Color fundus image. 2048 by 1536 pixels.
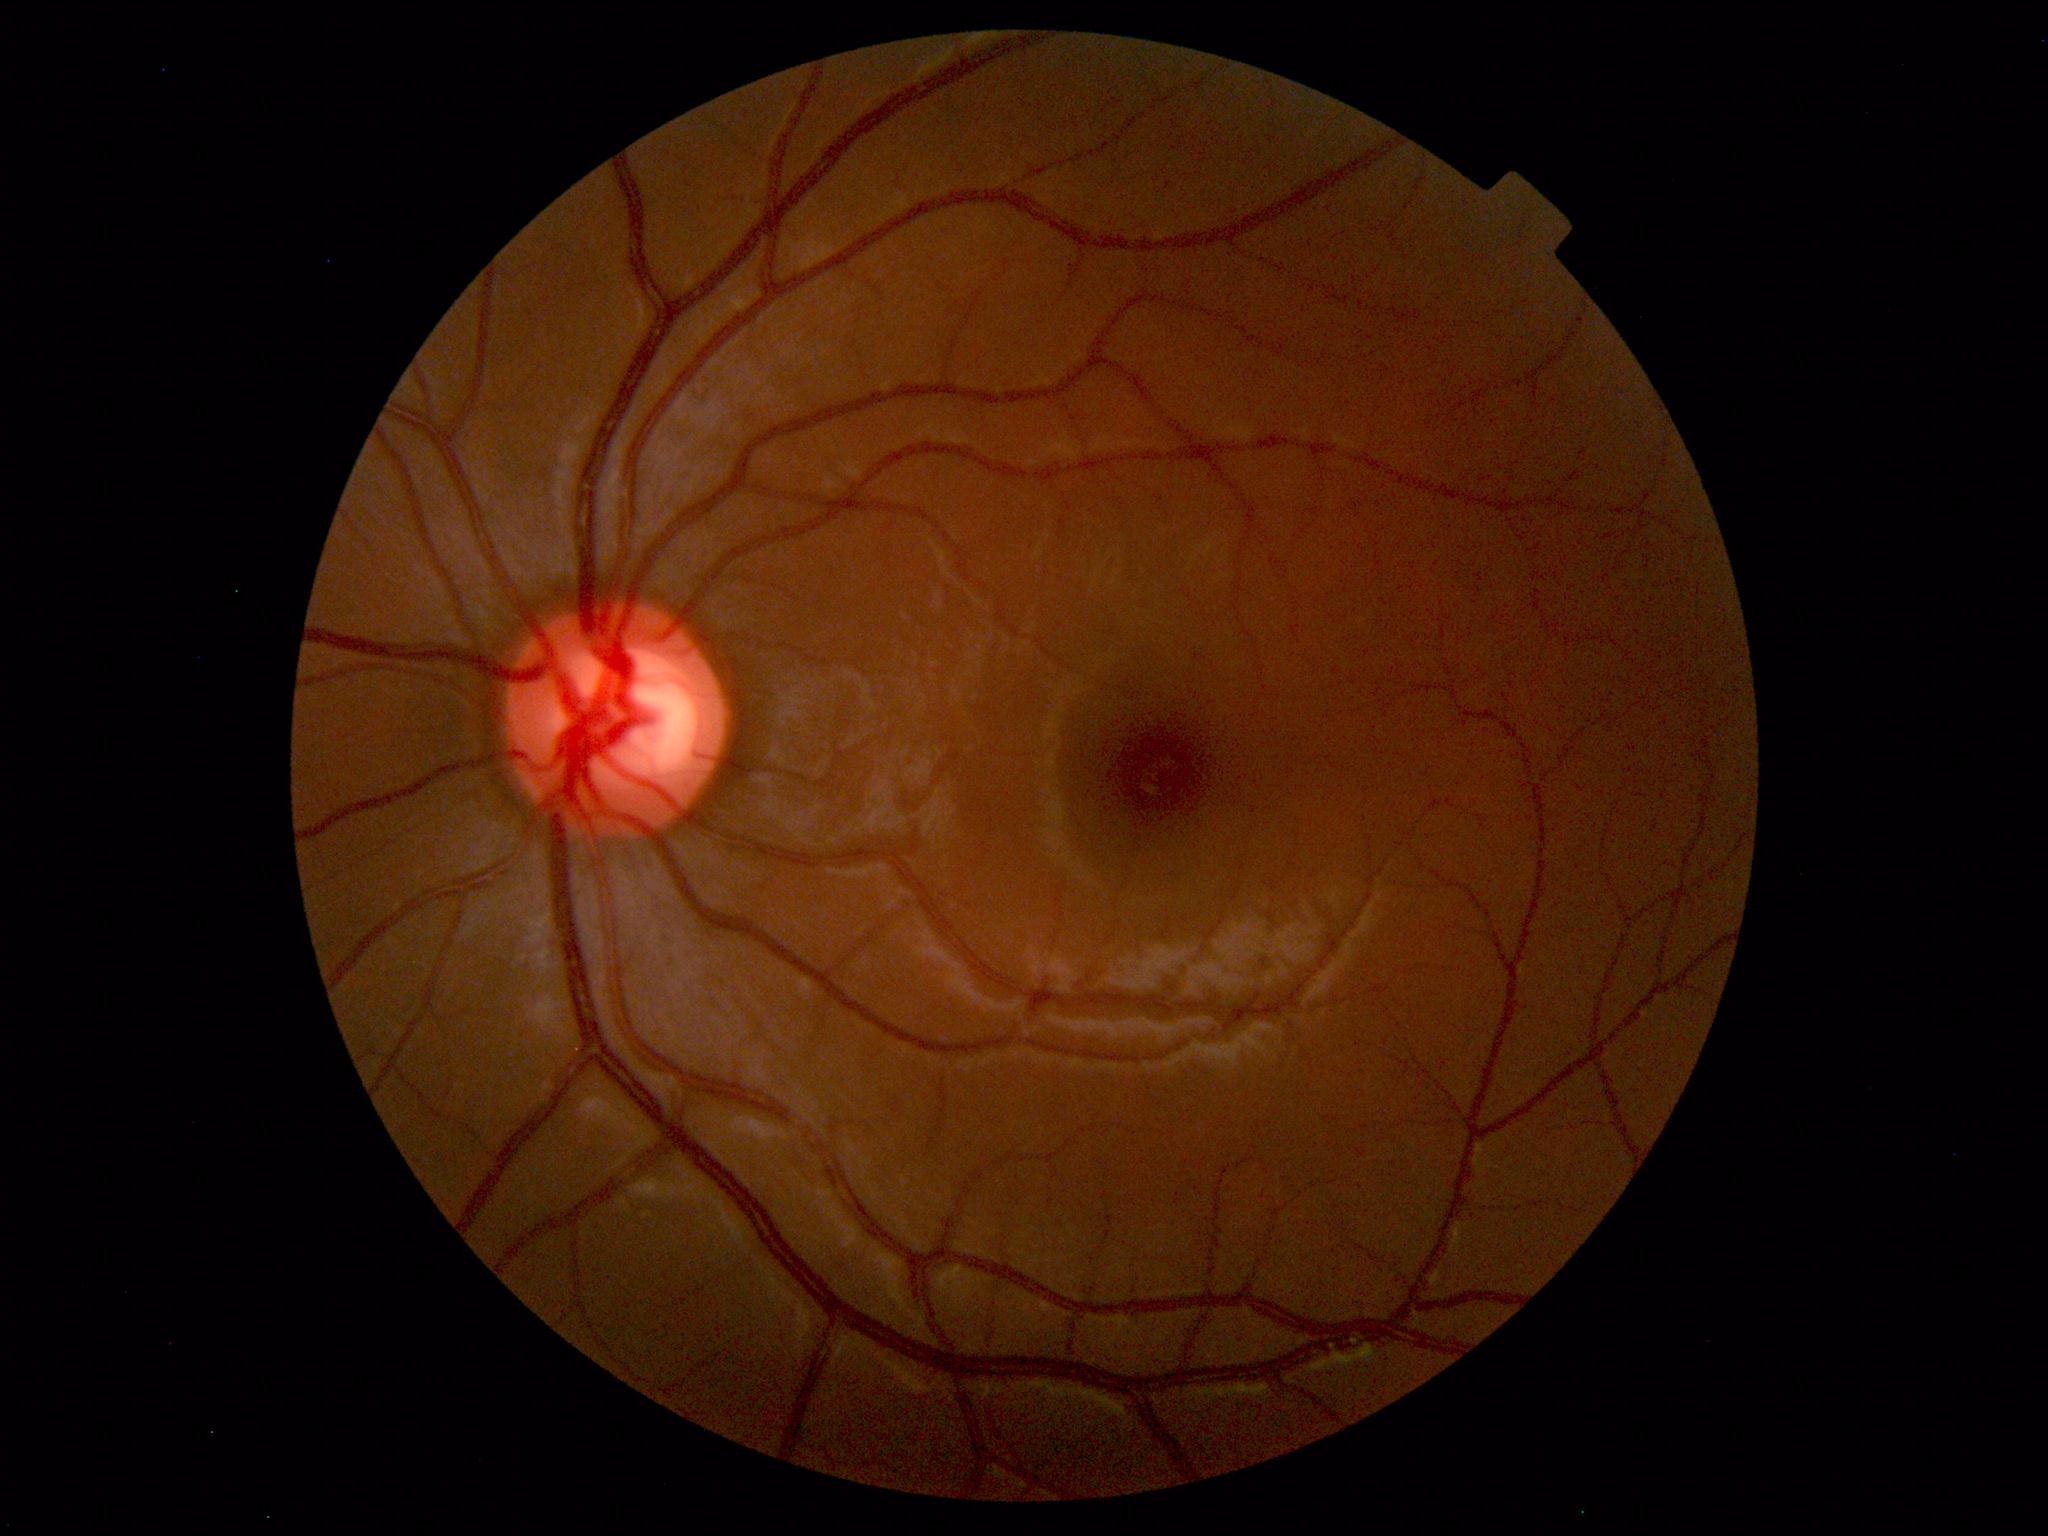 Within normal limits. No abnormalities identified.